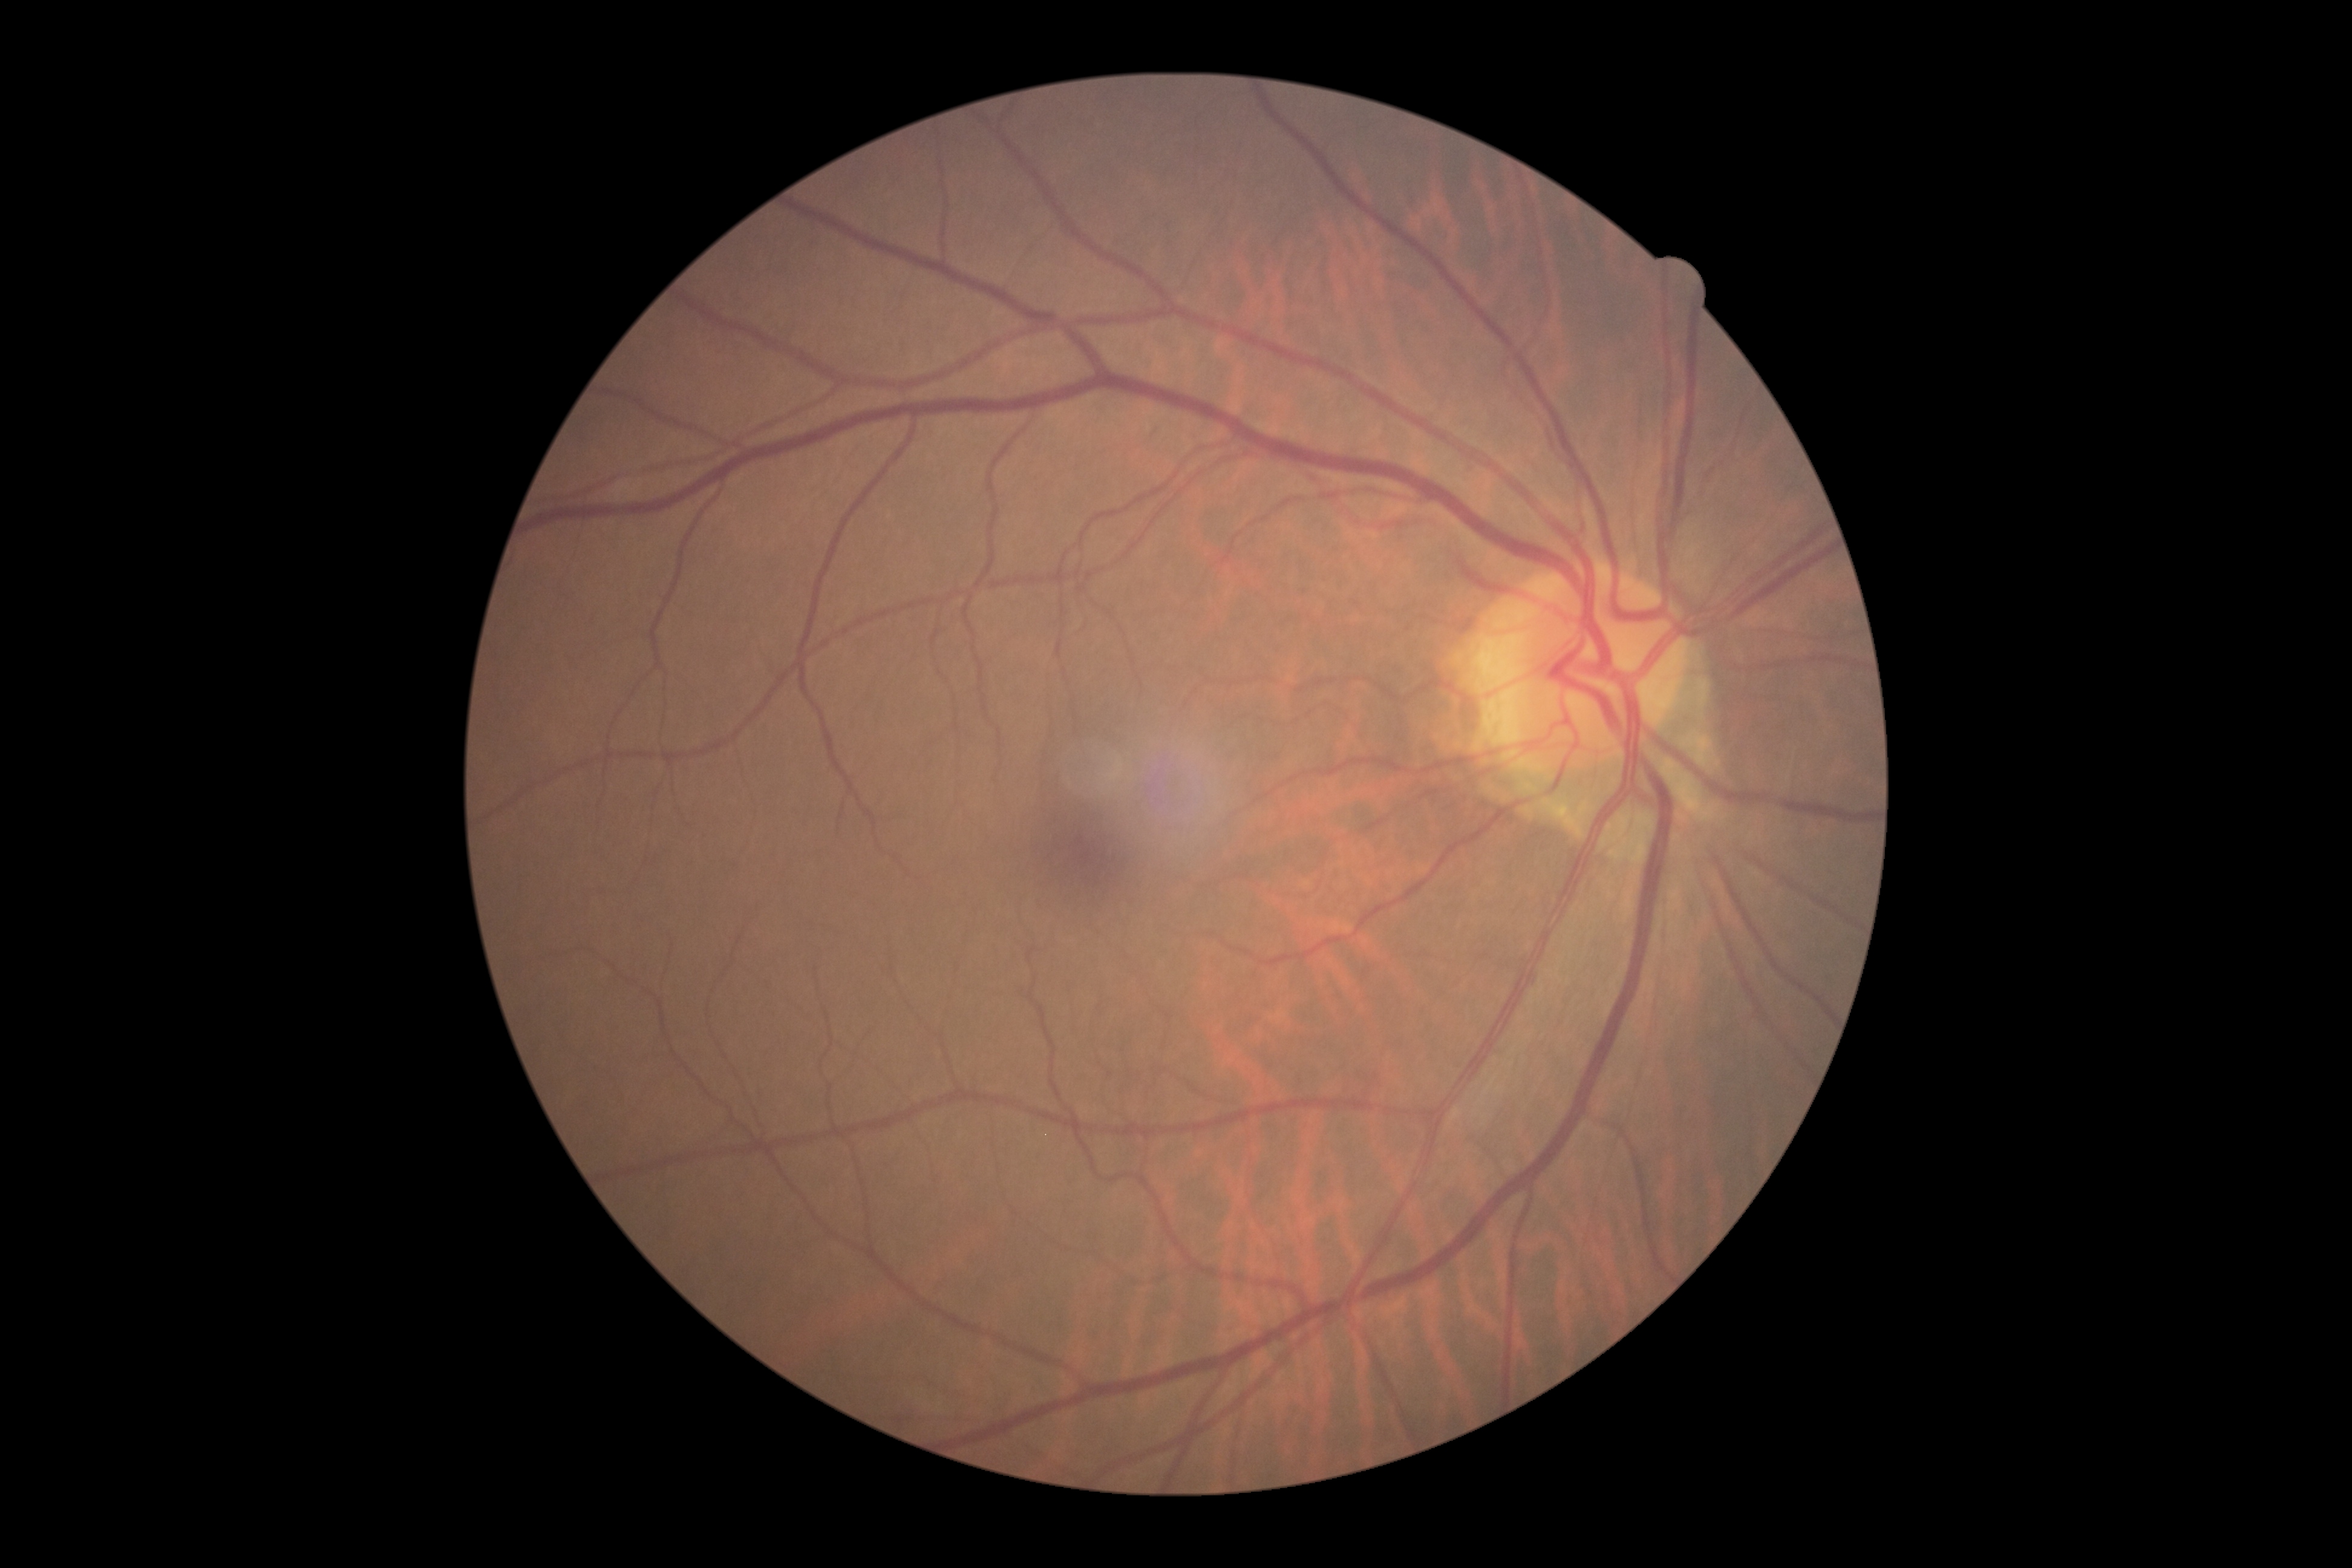
diabetic retinopathy (DR): 0 — no visible signs of diabetic retinopathy.